848x848px, FOV: 45 degrees
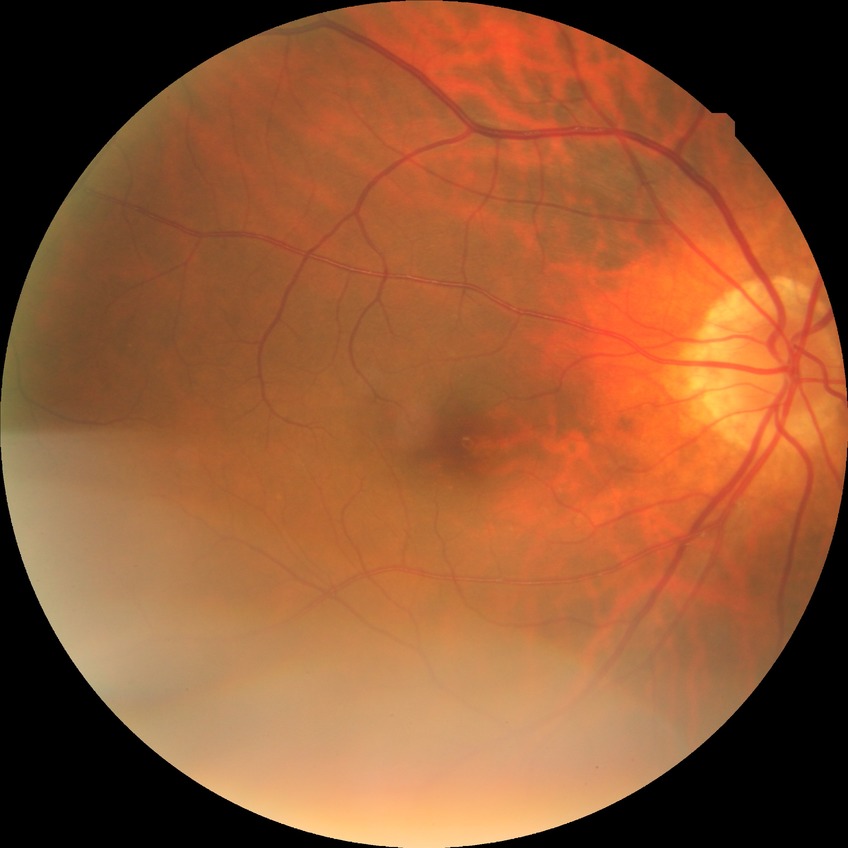

Diabetic retinopathy severity is no diabetic retinopathy.